FOV: 45 degrees:
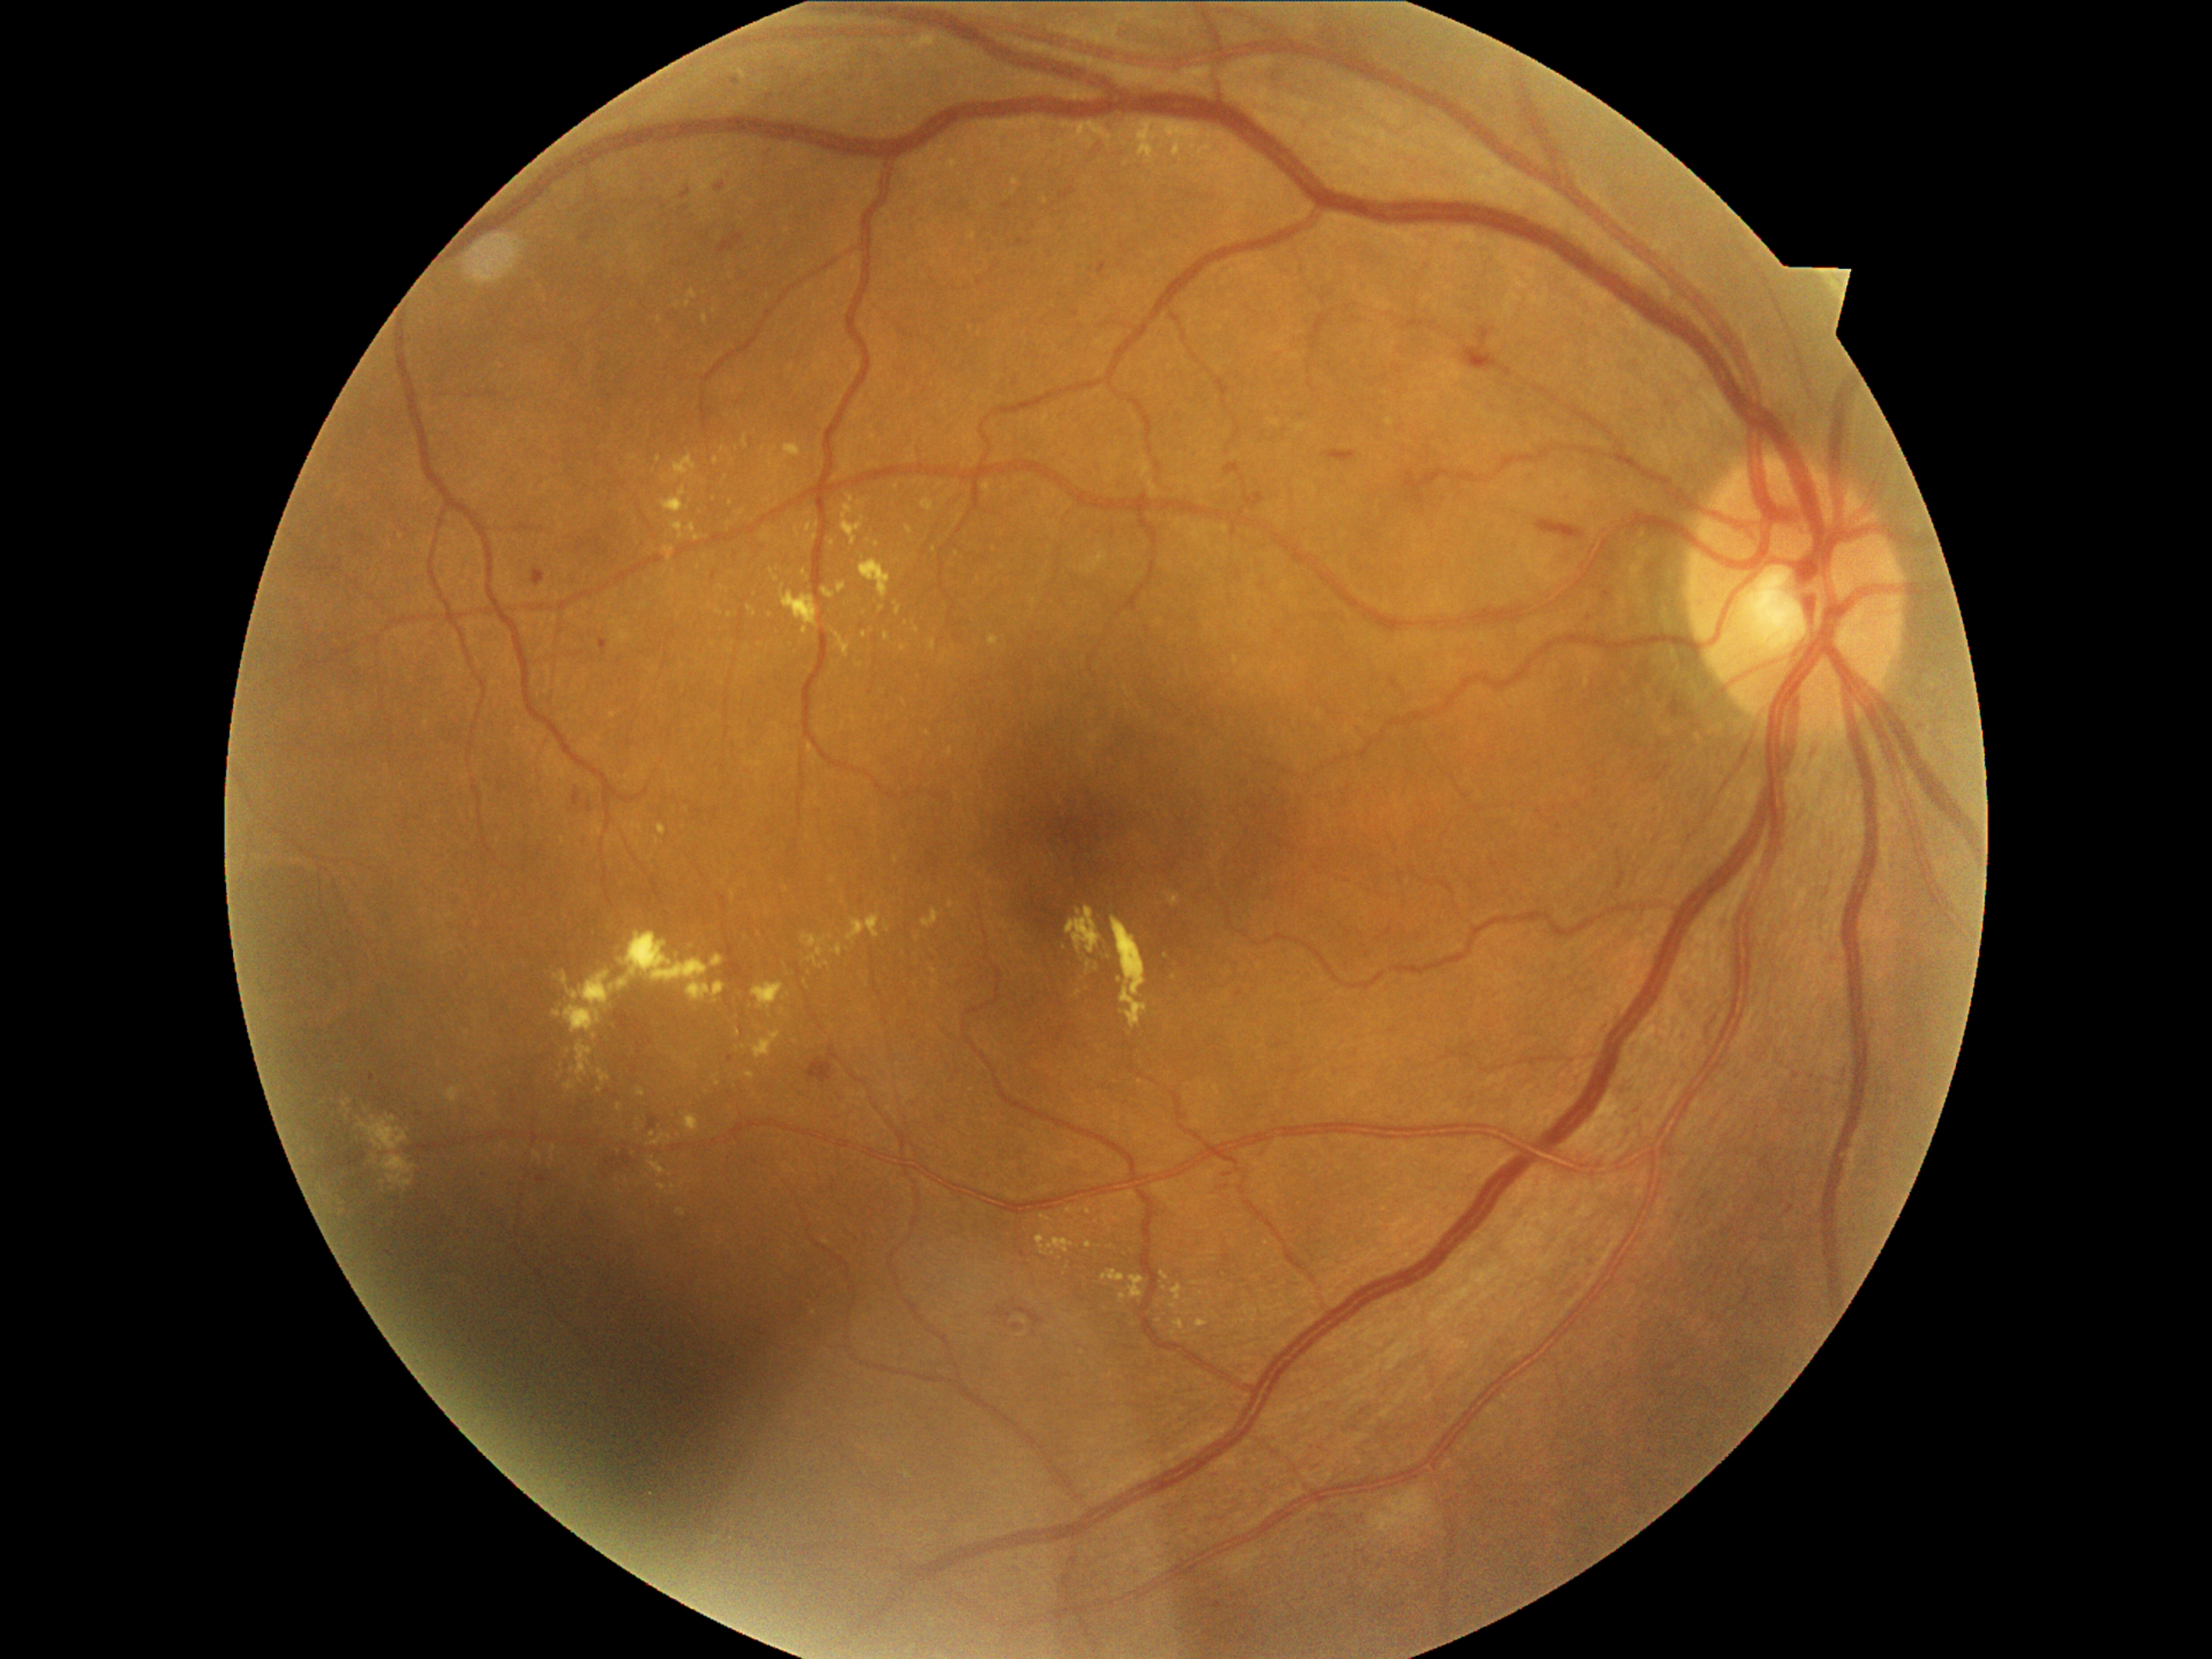 {"partial": true, "dr_grade": 2, "dr_grade_name": "moderate NPDR", "lesions": {"ex": [[661, 487, 690, 515], [842, 496, 864, 545], [921, 499, 934, 513], [950, 900, 955, 909], [736, 509, 747, 516], [684, 1114, 699, 1132], [1160, 122, 1170, 132], [1112, 916, 1150, 1028], [803, 571, 812, 581], [762, 535, 771, 542], [1161, 136, 1173, 146]], "ex_small": [[600, 1090], [868, 541], [723, 449], [815, 538], [944, 656], [1121, 980], [347, 1105], [1110, 957]]}}